Fundus photo · 2352 x 1568 pixels: 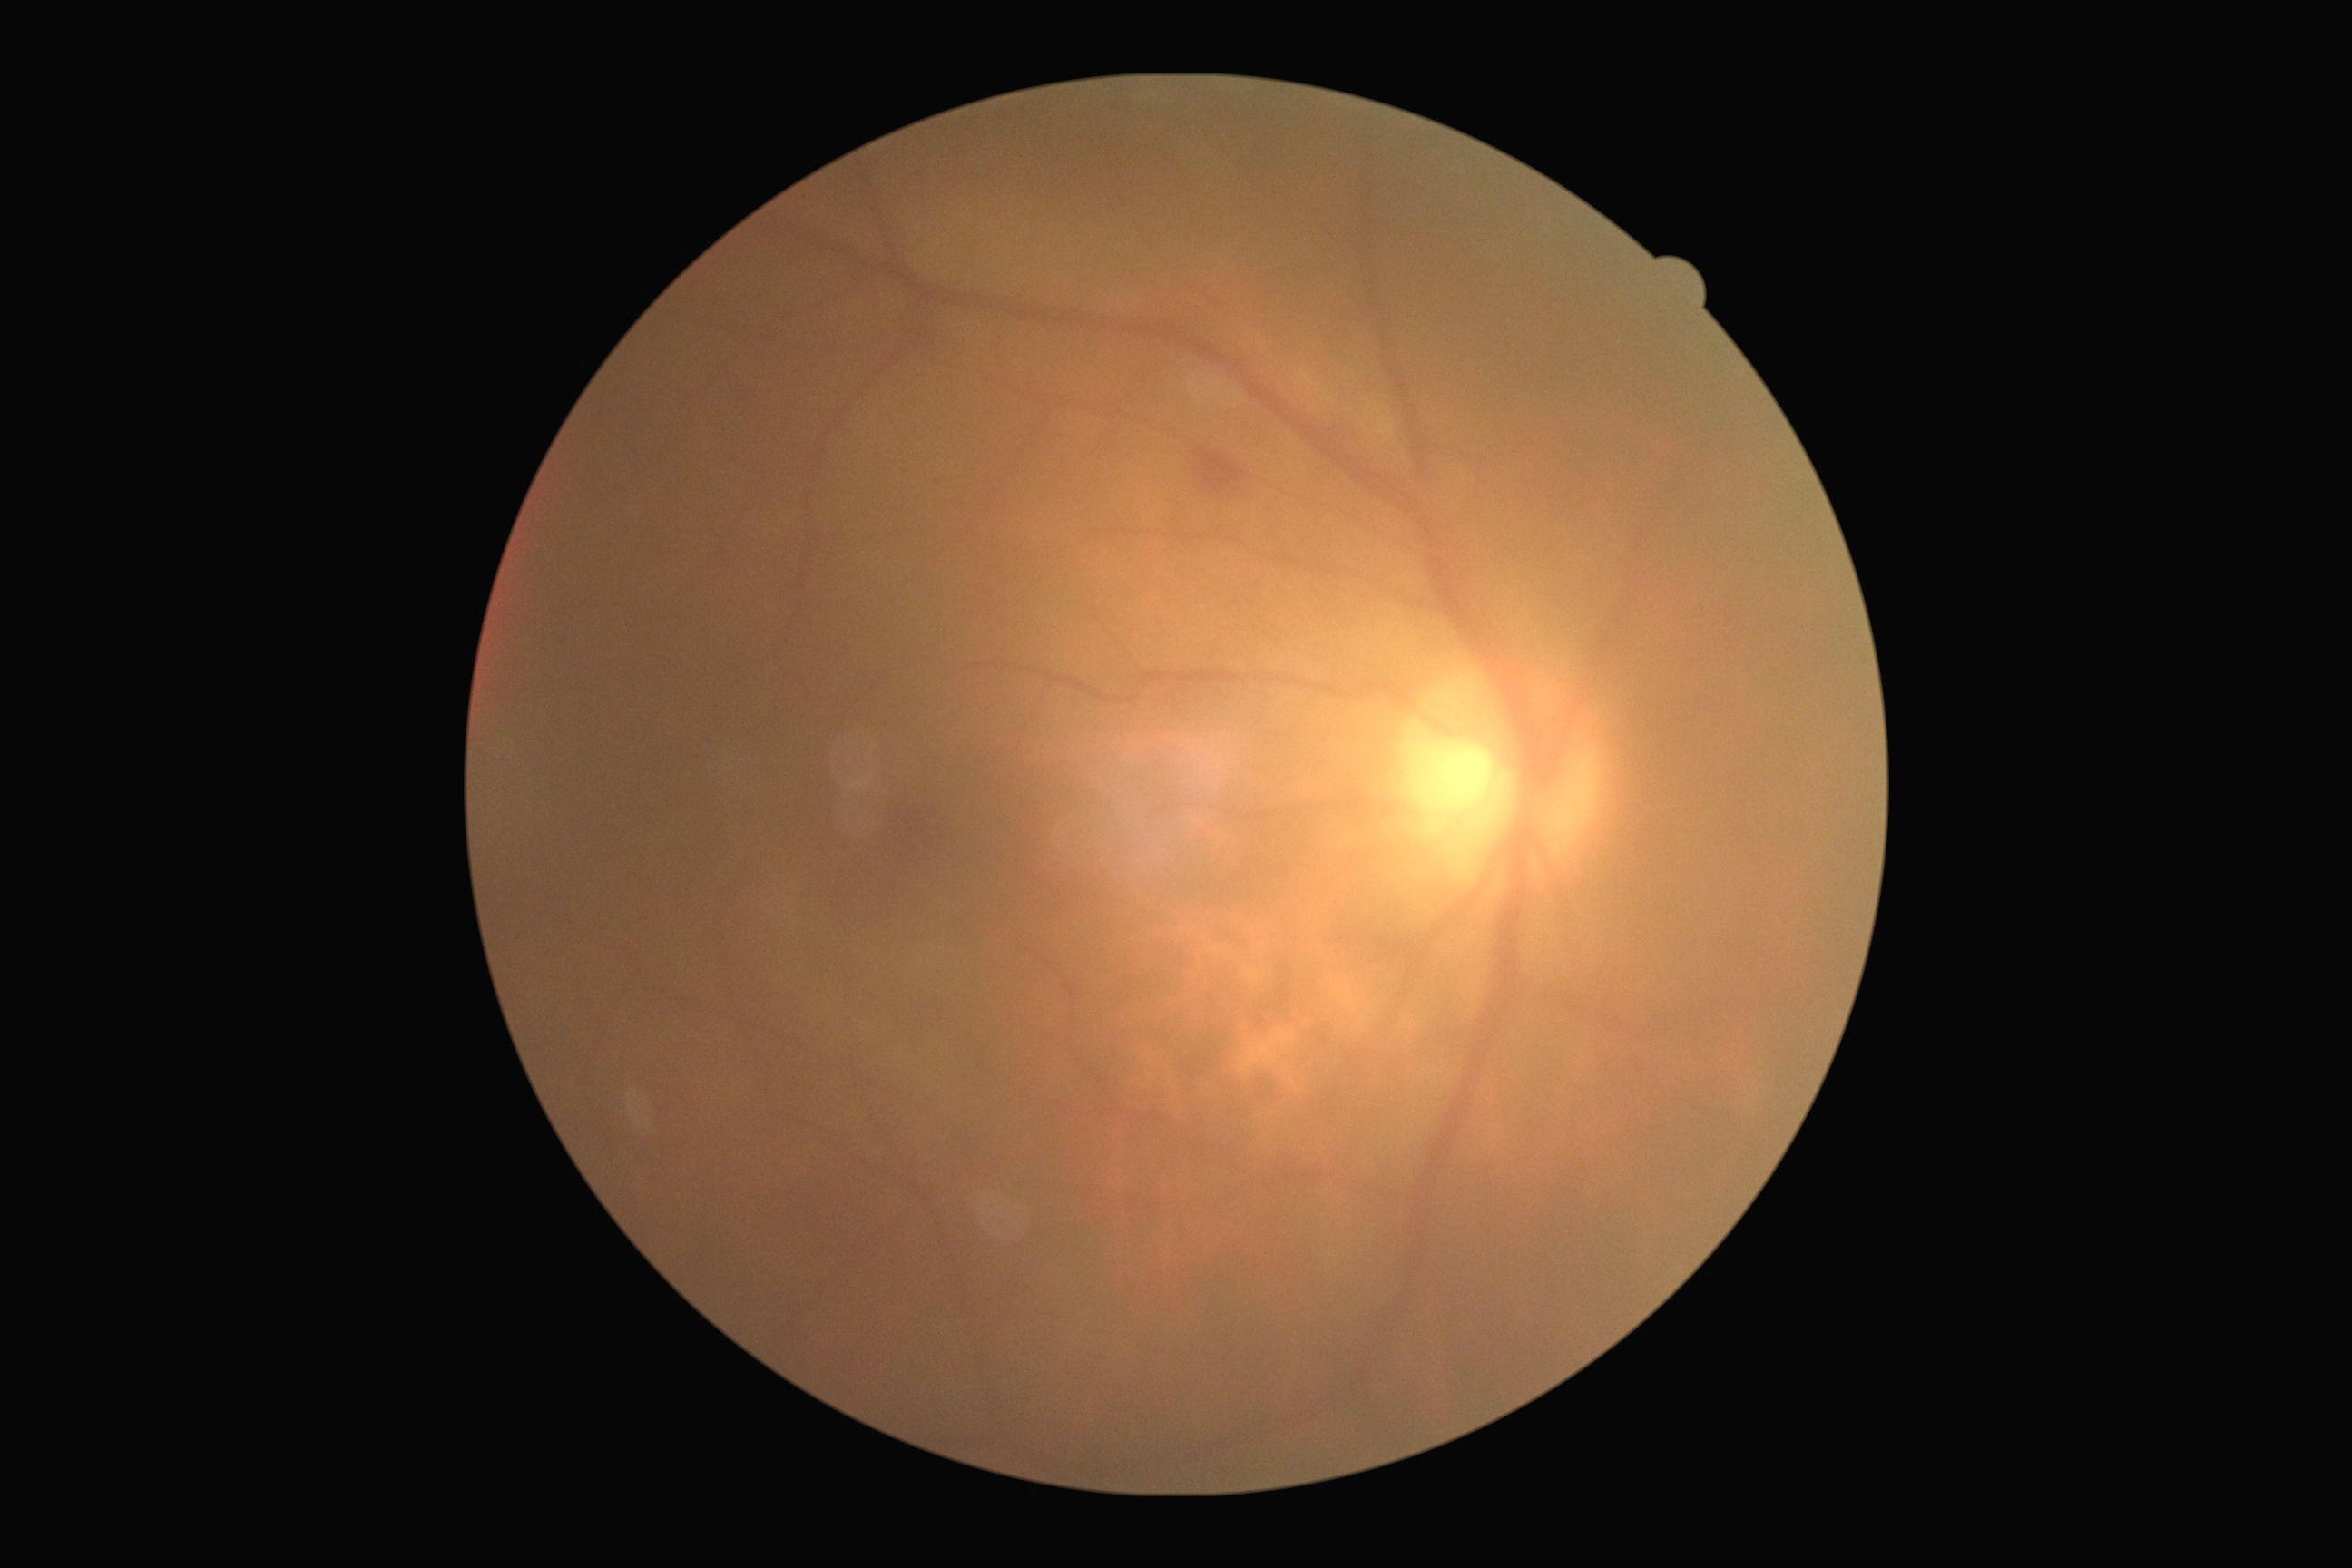
DR stage: grade 2 (moderate NPDR).